Fundus photo; Remidio FOP fundus camera
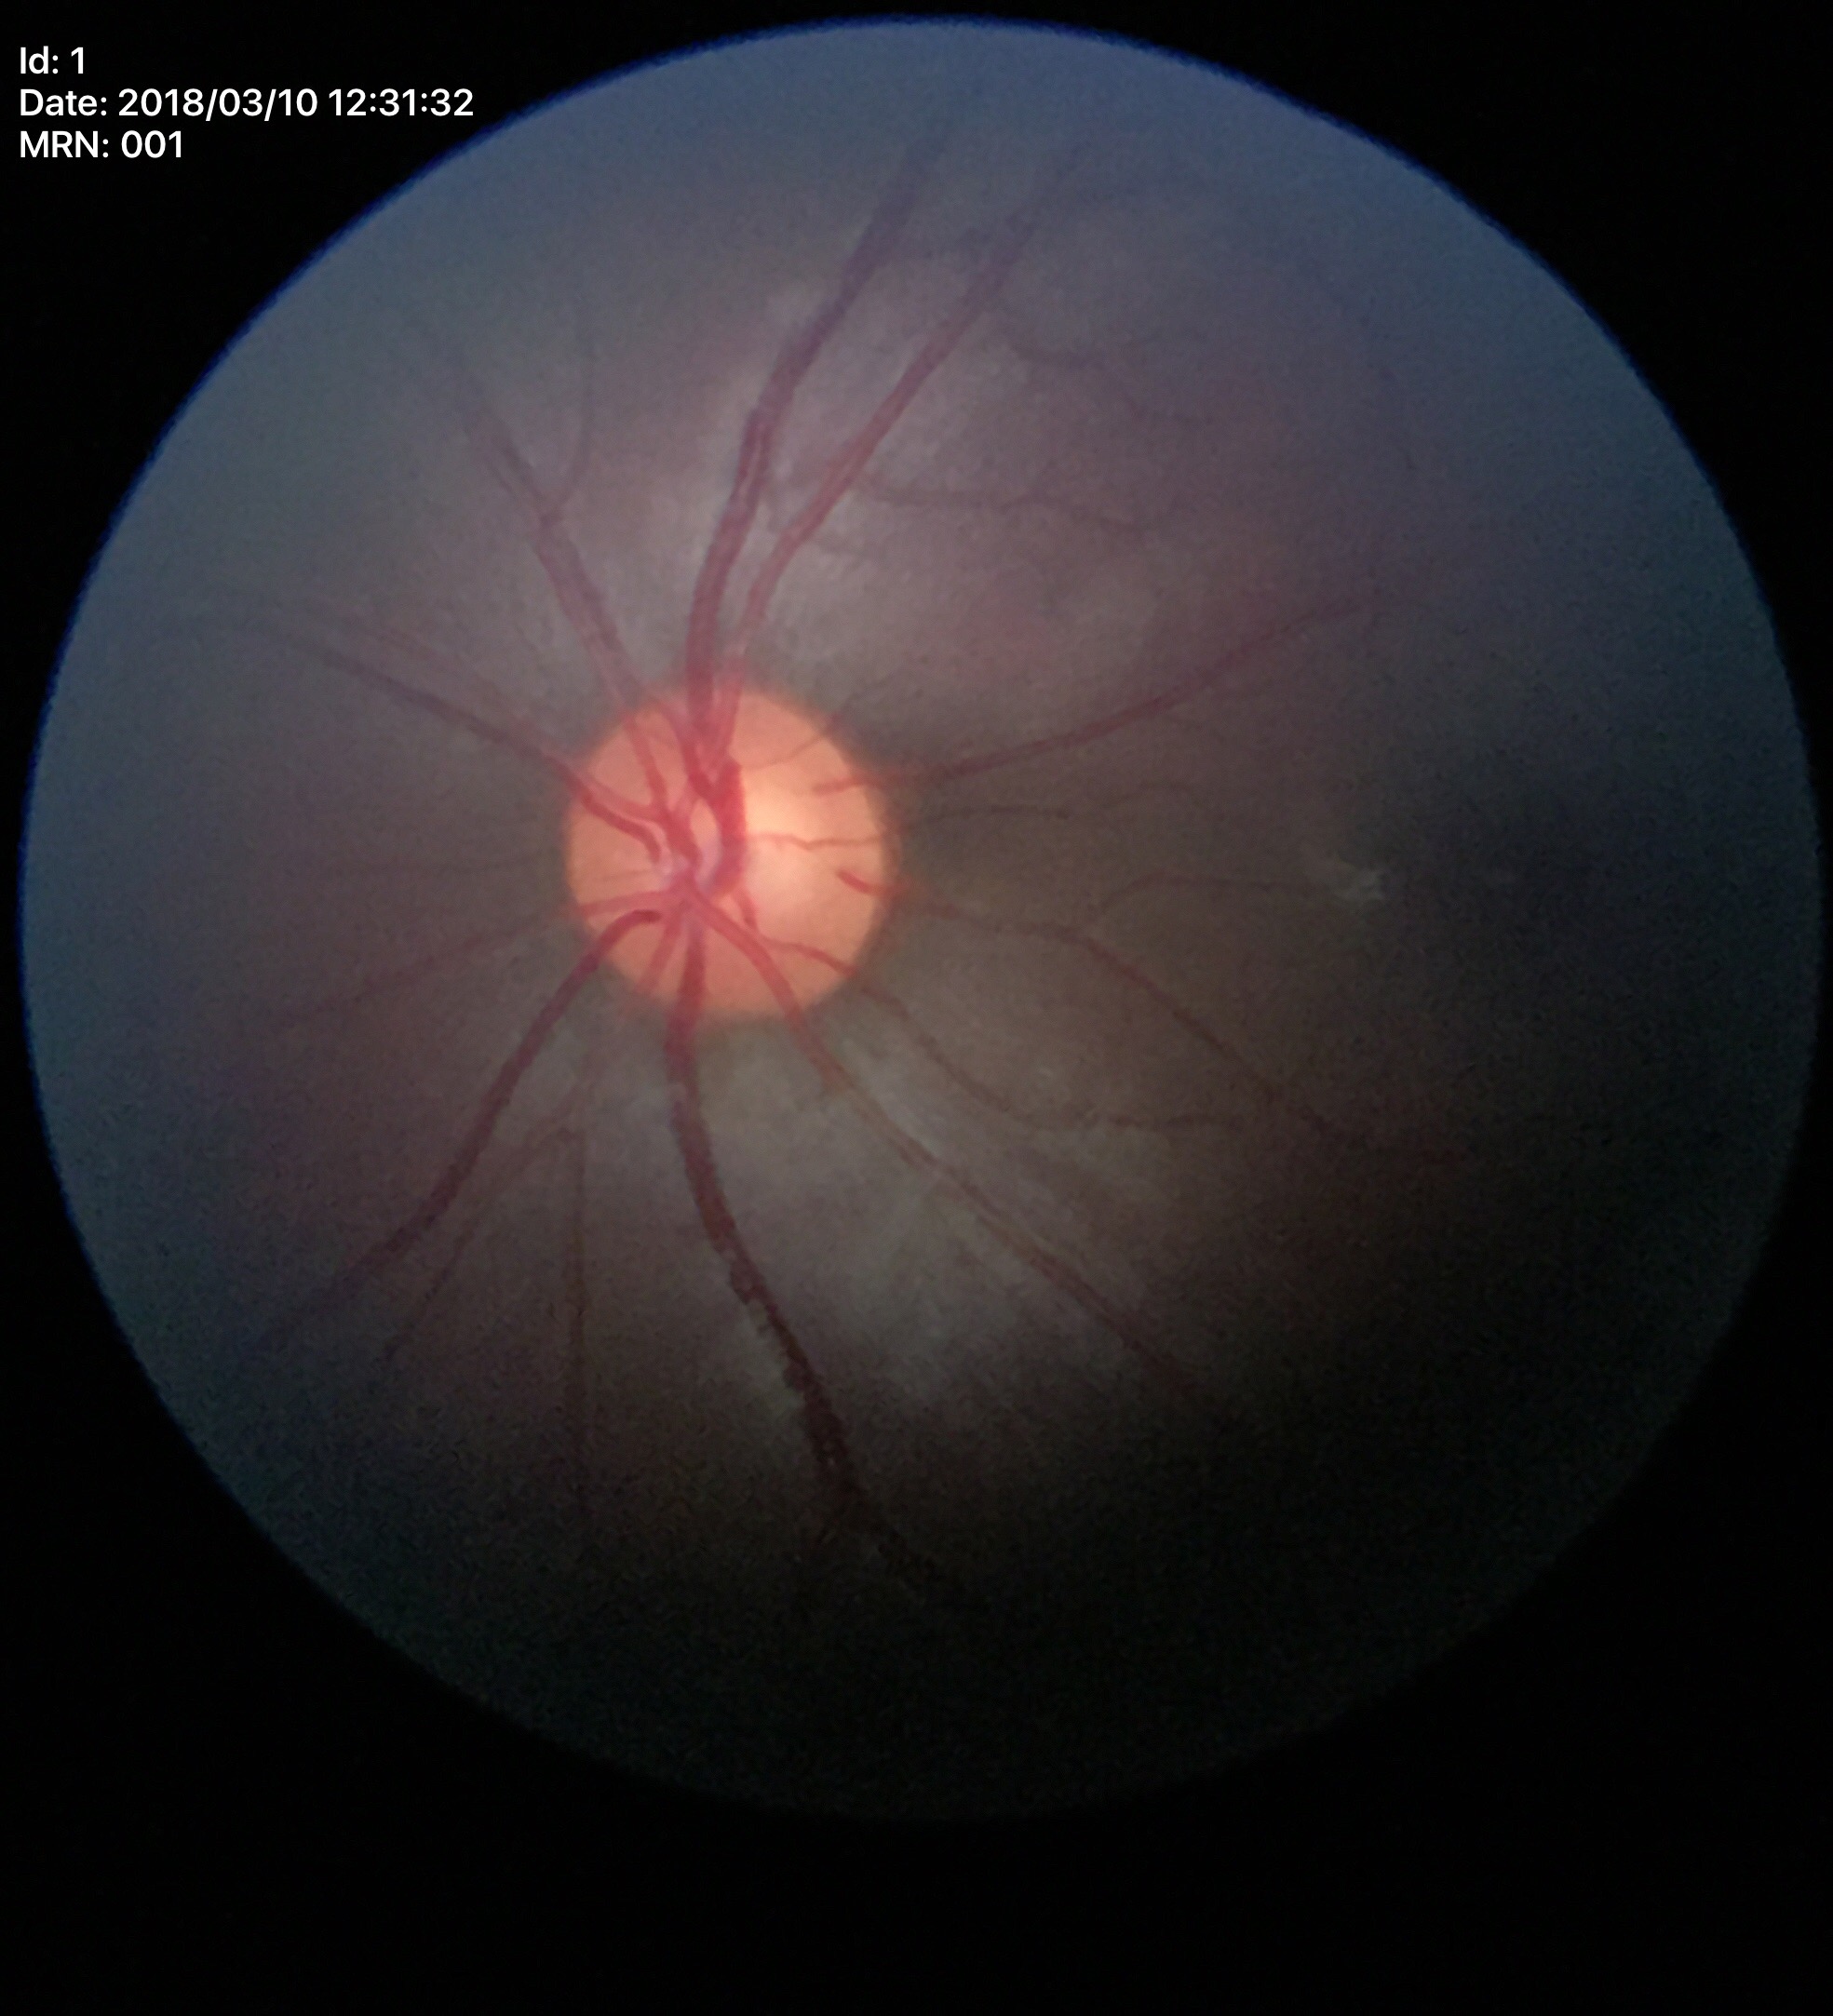 Glaucoma decision: no suspicious findings.
Vertical C/D ratio of 0.55.
Horizontal C/D ratio: 0.56.
Area cup-to-disc ratio is 0.30.